Retinal fundus photograph. 2048x1536. 45° FOV:
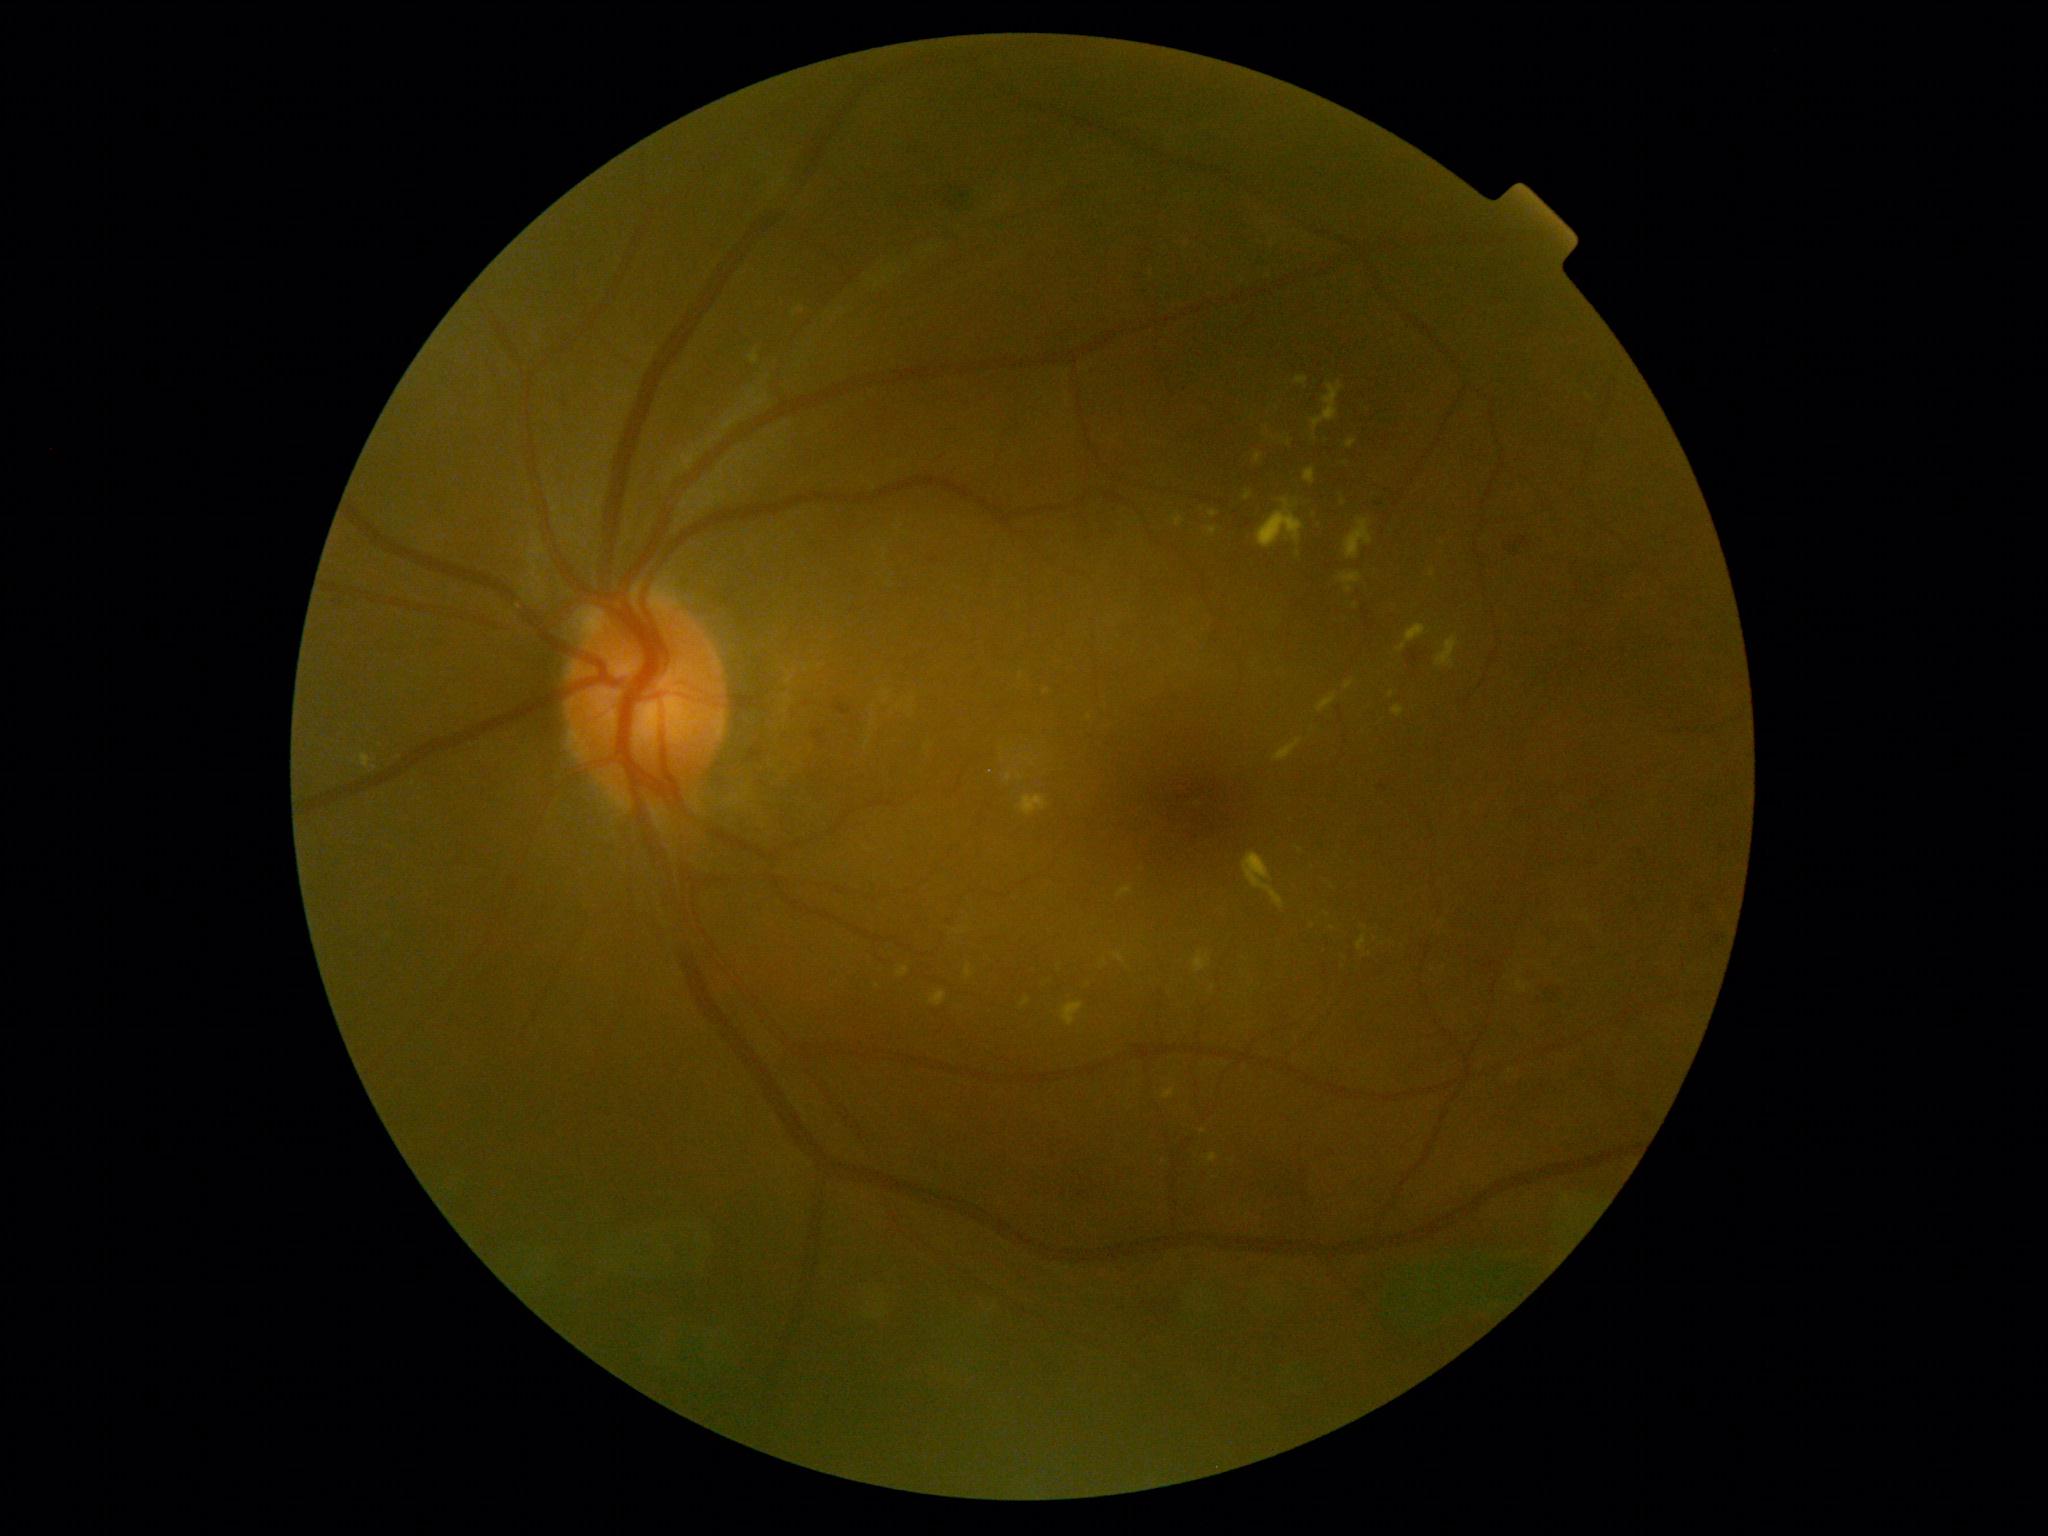
DR grade: moderate NPDR (2)
Lesions identified (partial list):
EXs (continued): bbox=(361, 753, 371, 769); bbox=(1347, 440, 1357, 448); bbox=(1172, 517, 1185, 527); bbox=(1312, 382, 1344, 431); bbox=(1118, 886, 1133, 898); bbox=(1082, 975, 1090, 988); bbox=(1206, 527, 1218, 537); bbox=(1019, 795, 1049, 816); bbox=(1113, 952, 1125, 964); bbox=(1209, 511, 1219, 518); bbox=(1437, 636, 1460, 667); bbox=(1317, 693, 1337, 713)
Small EXs near Point(1020, 777); Point(1021, 675); Point(1343, 503); Point(1288, 443); Point(1333, 928); Point(1326, 914); Point(375, 768)